2352x1568. 45° field of view.
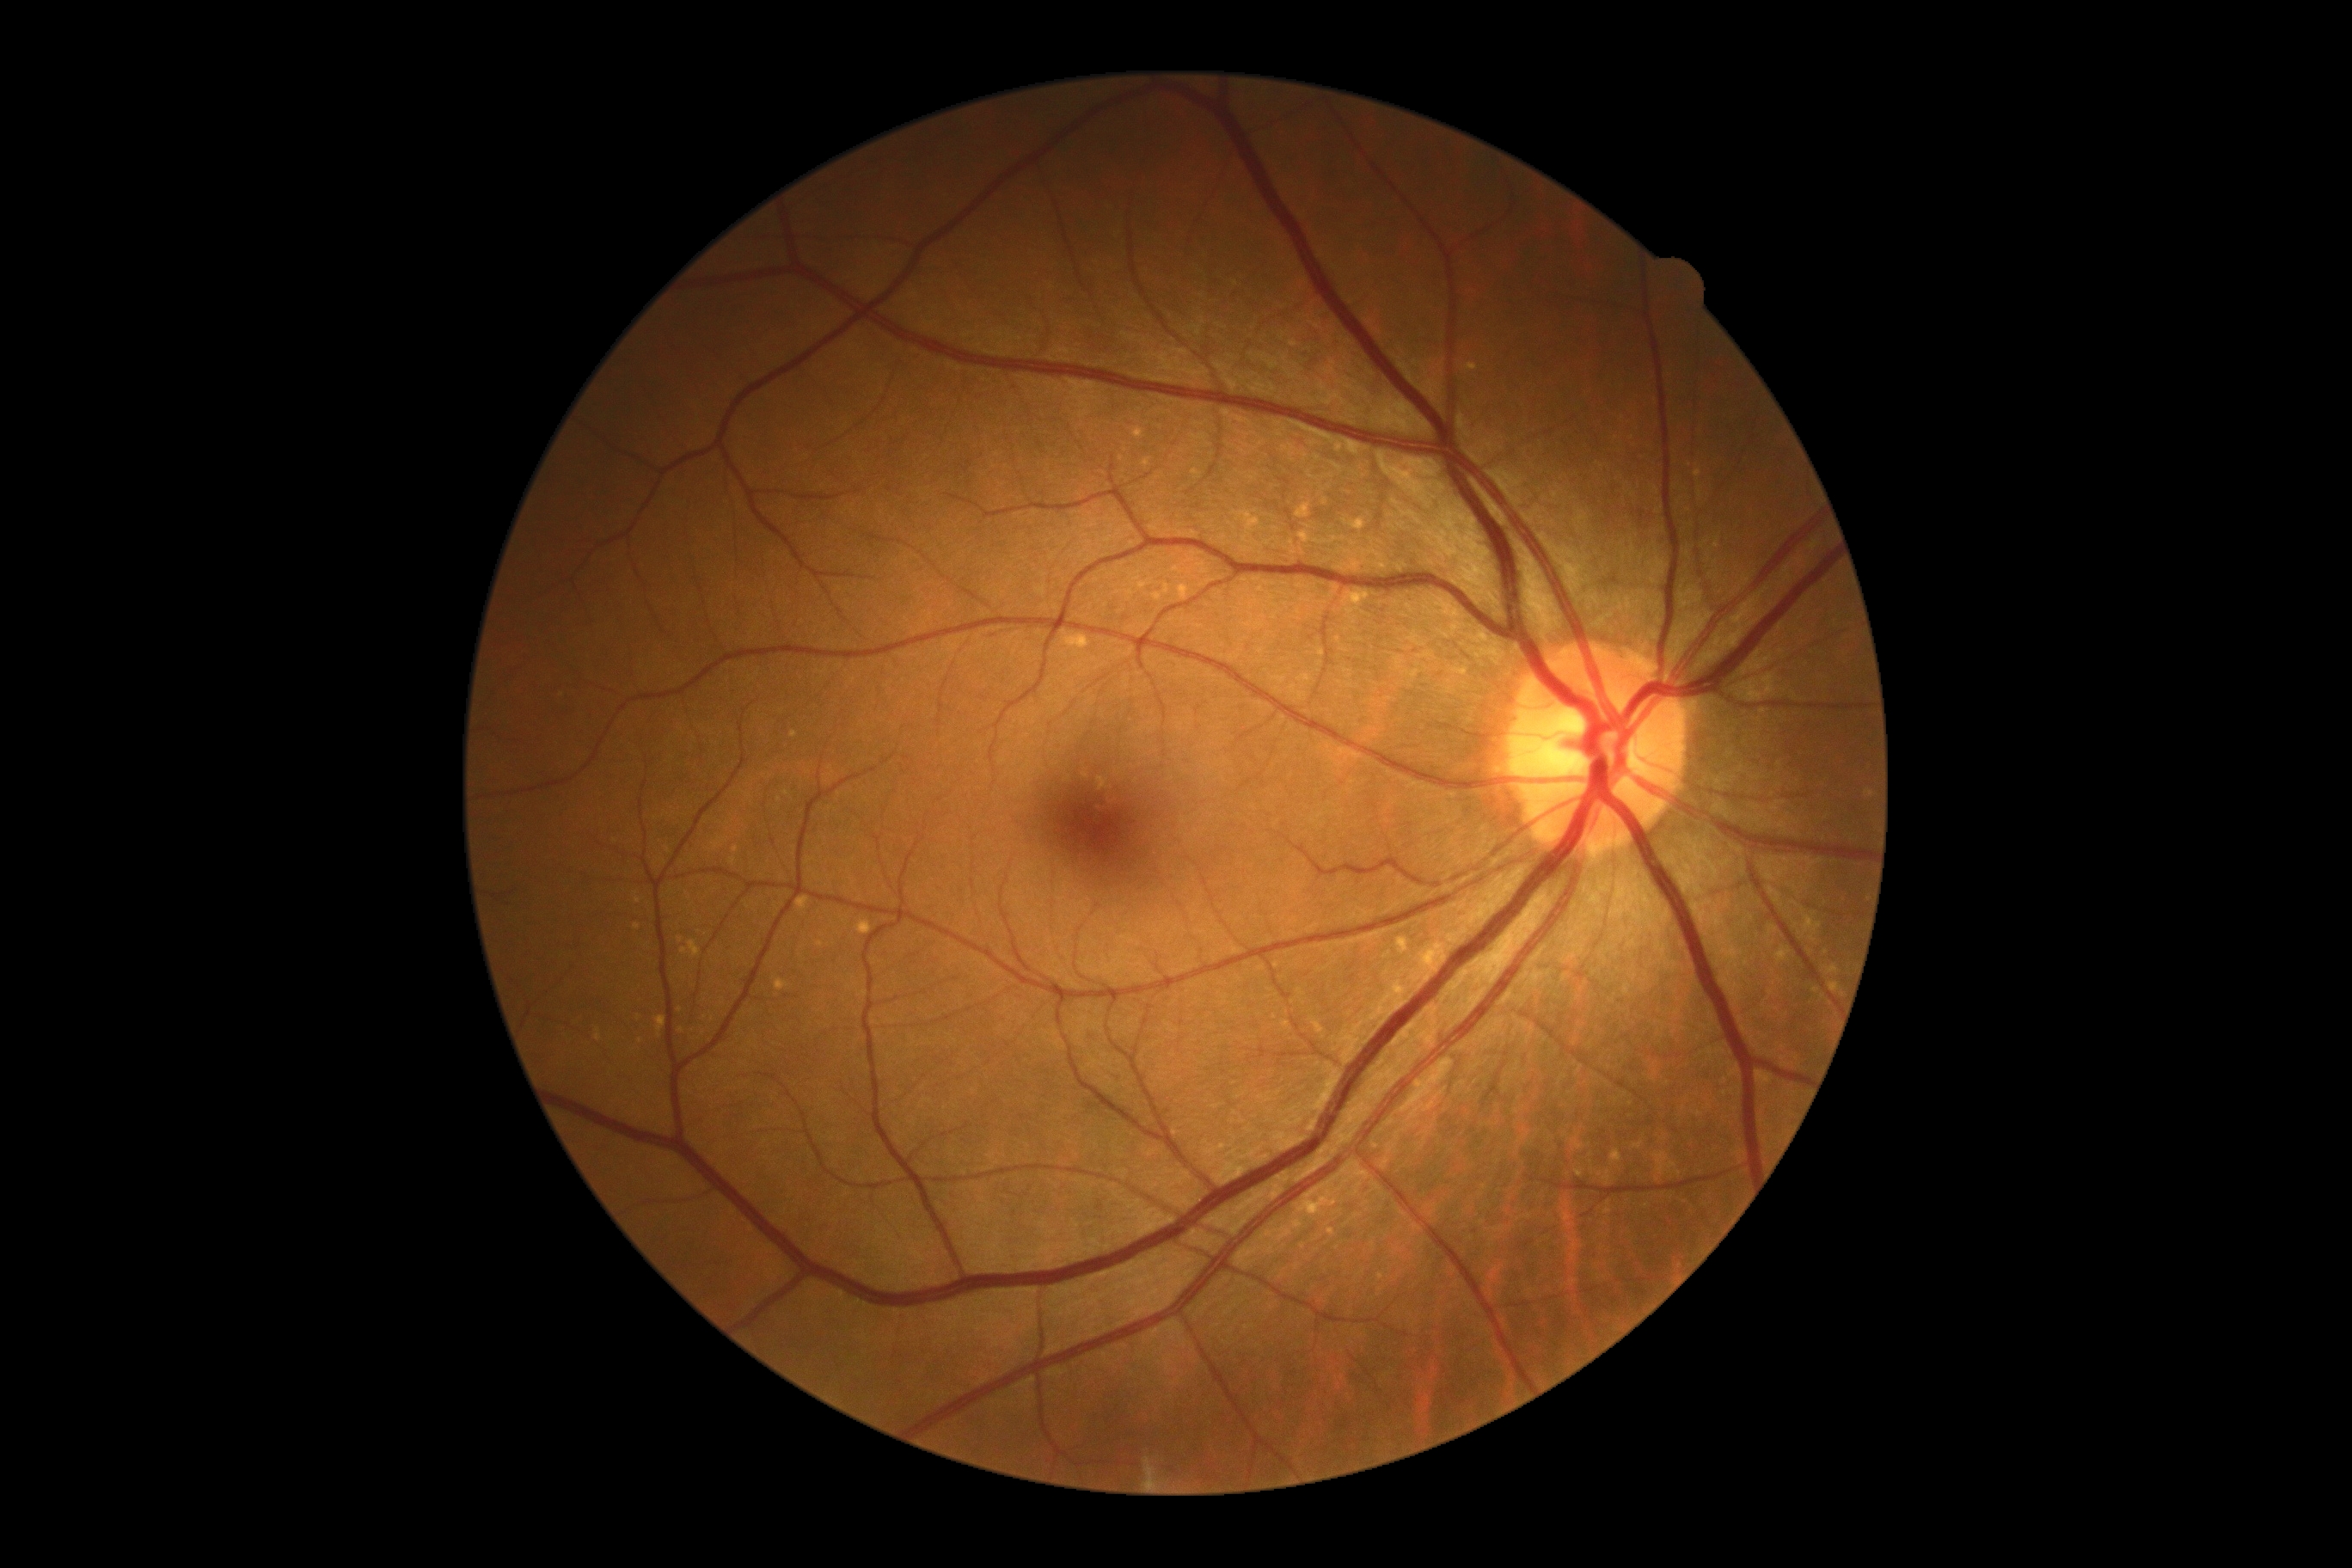

DR stage is grade 0 (no apparent retinopathy).